Modified Davis classification: 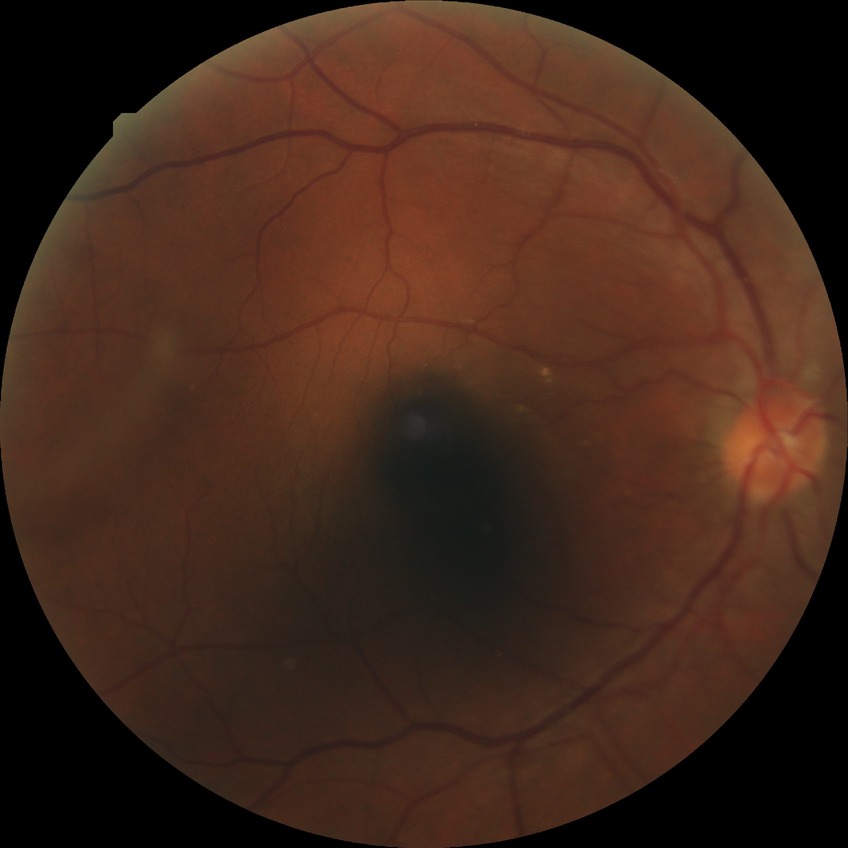
modified Davis grading = simple diabetic retinopathy.